Image size 2352x1568:
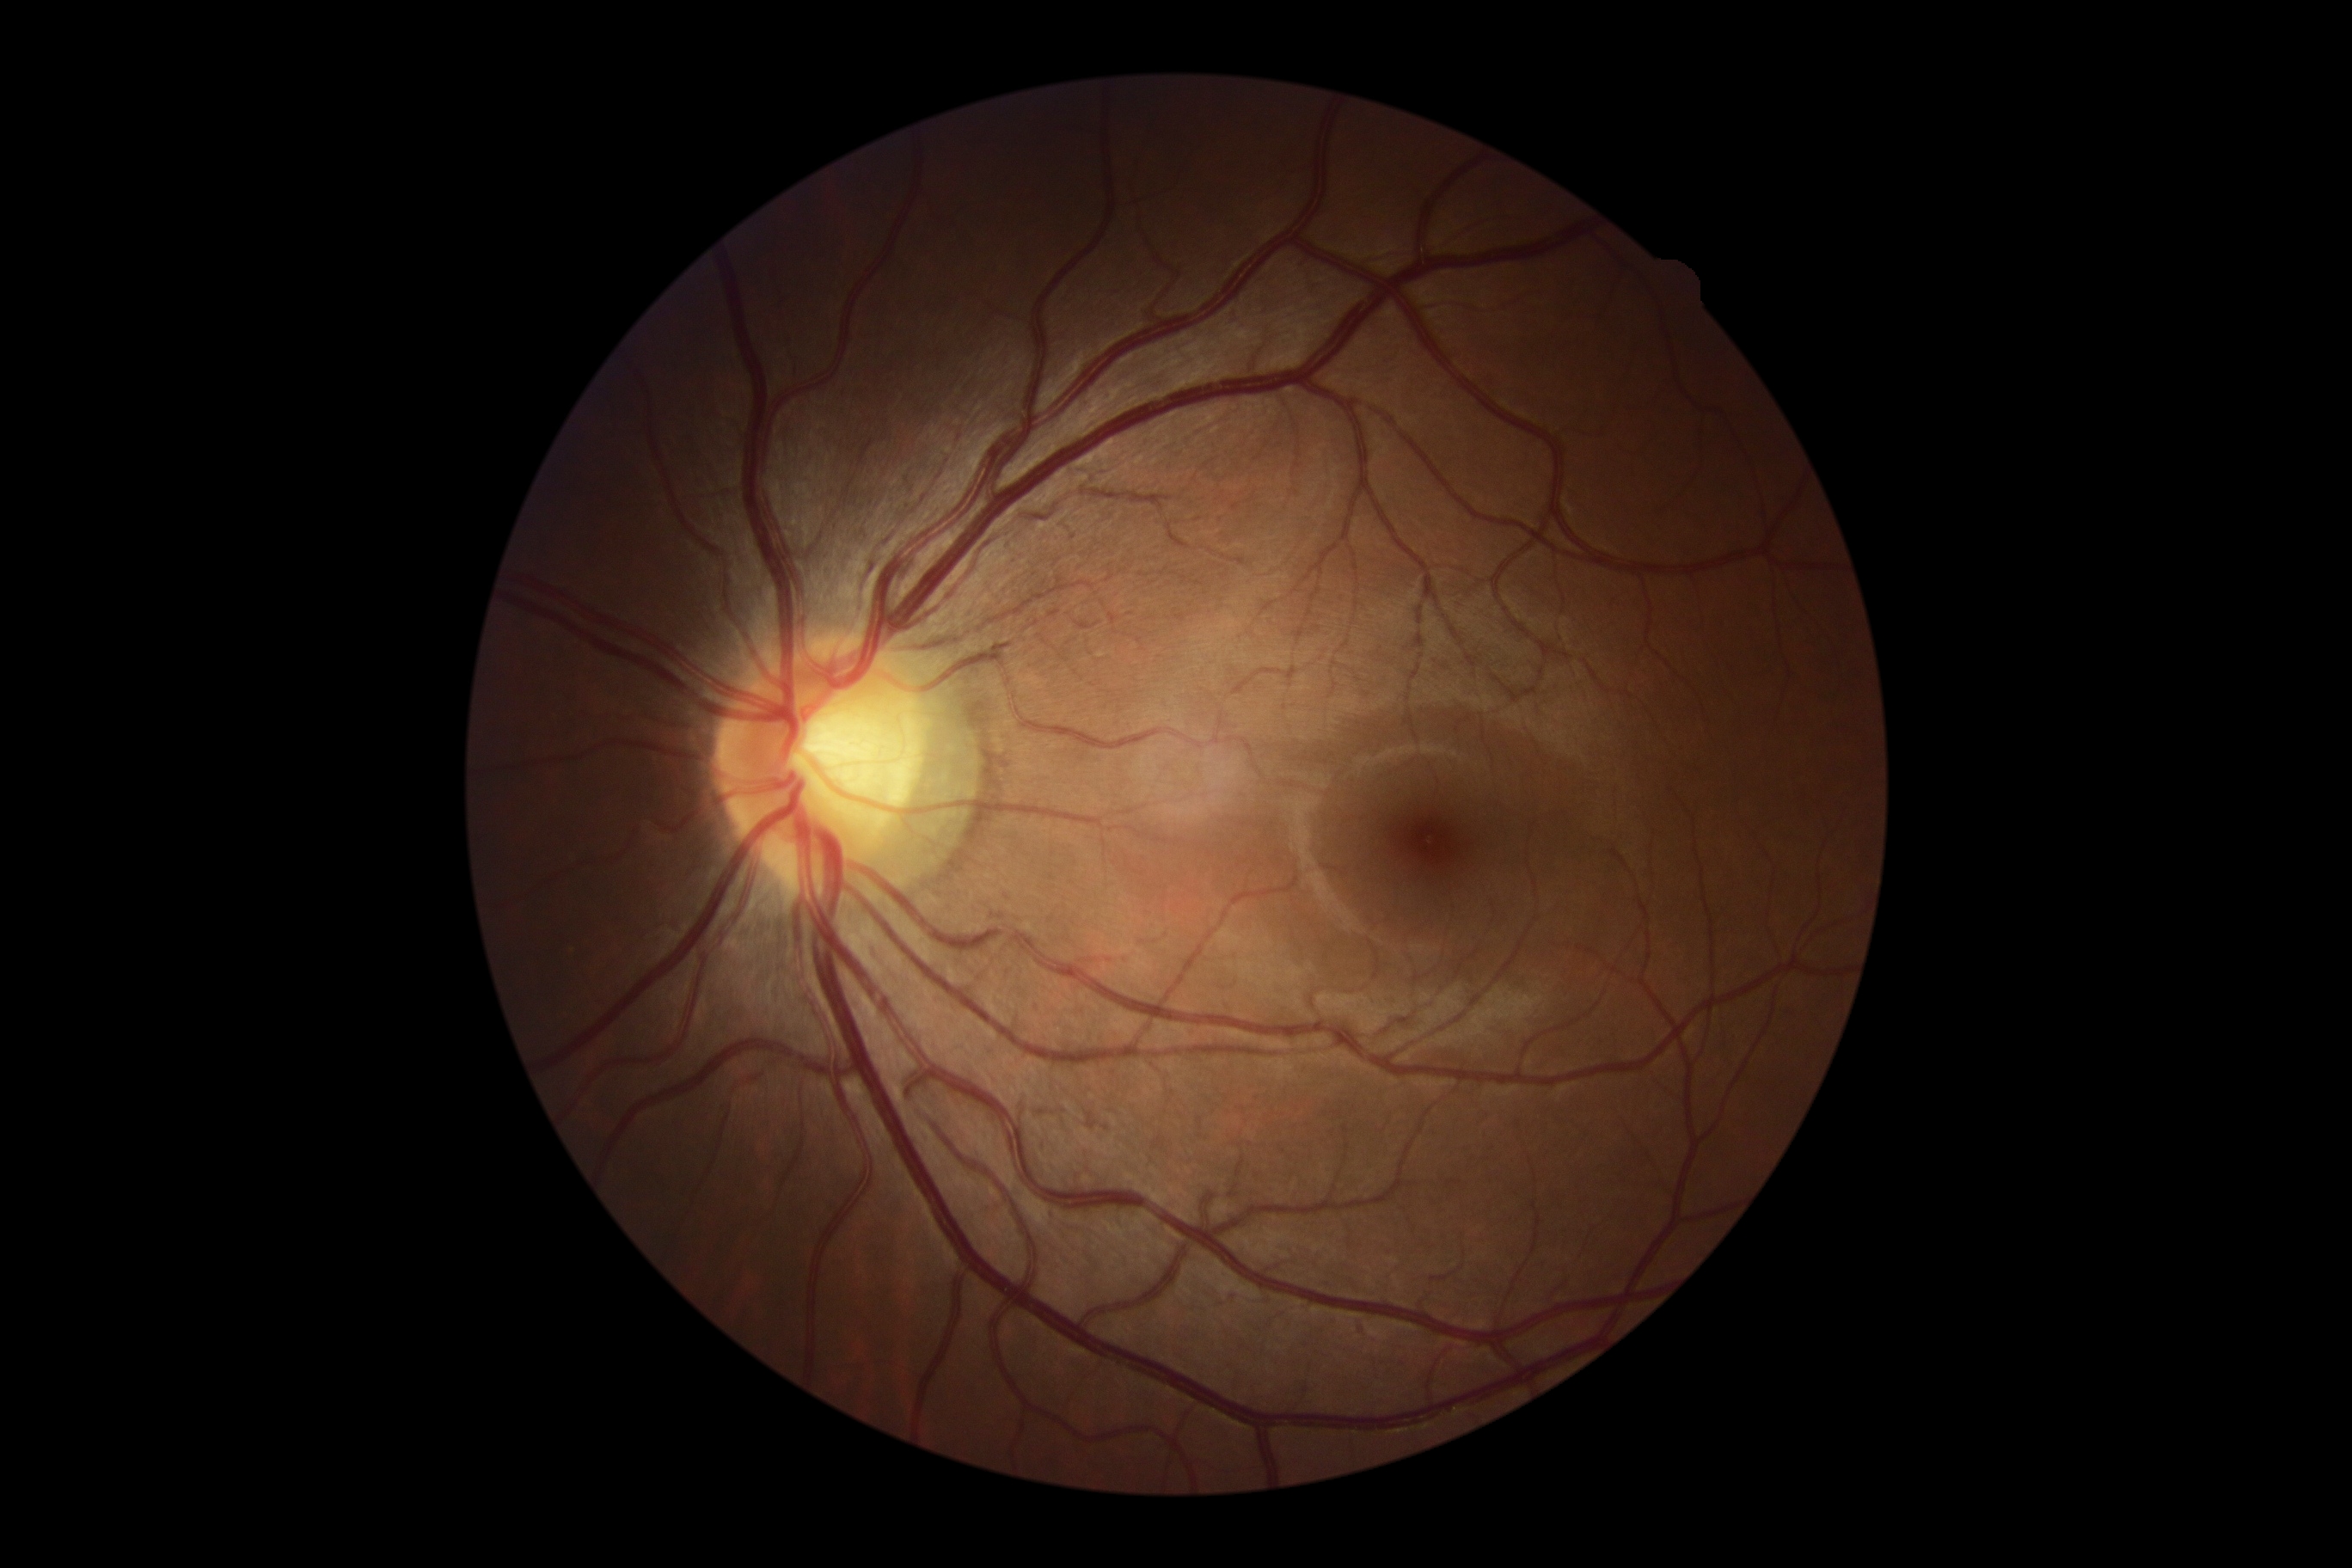
• diabetic retinopathy (DR) — grade 0 — no visible signs of diabetic retinopathy
• DR impression — no DR findings